FOV: 45 degrees · color fundus image: 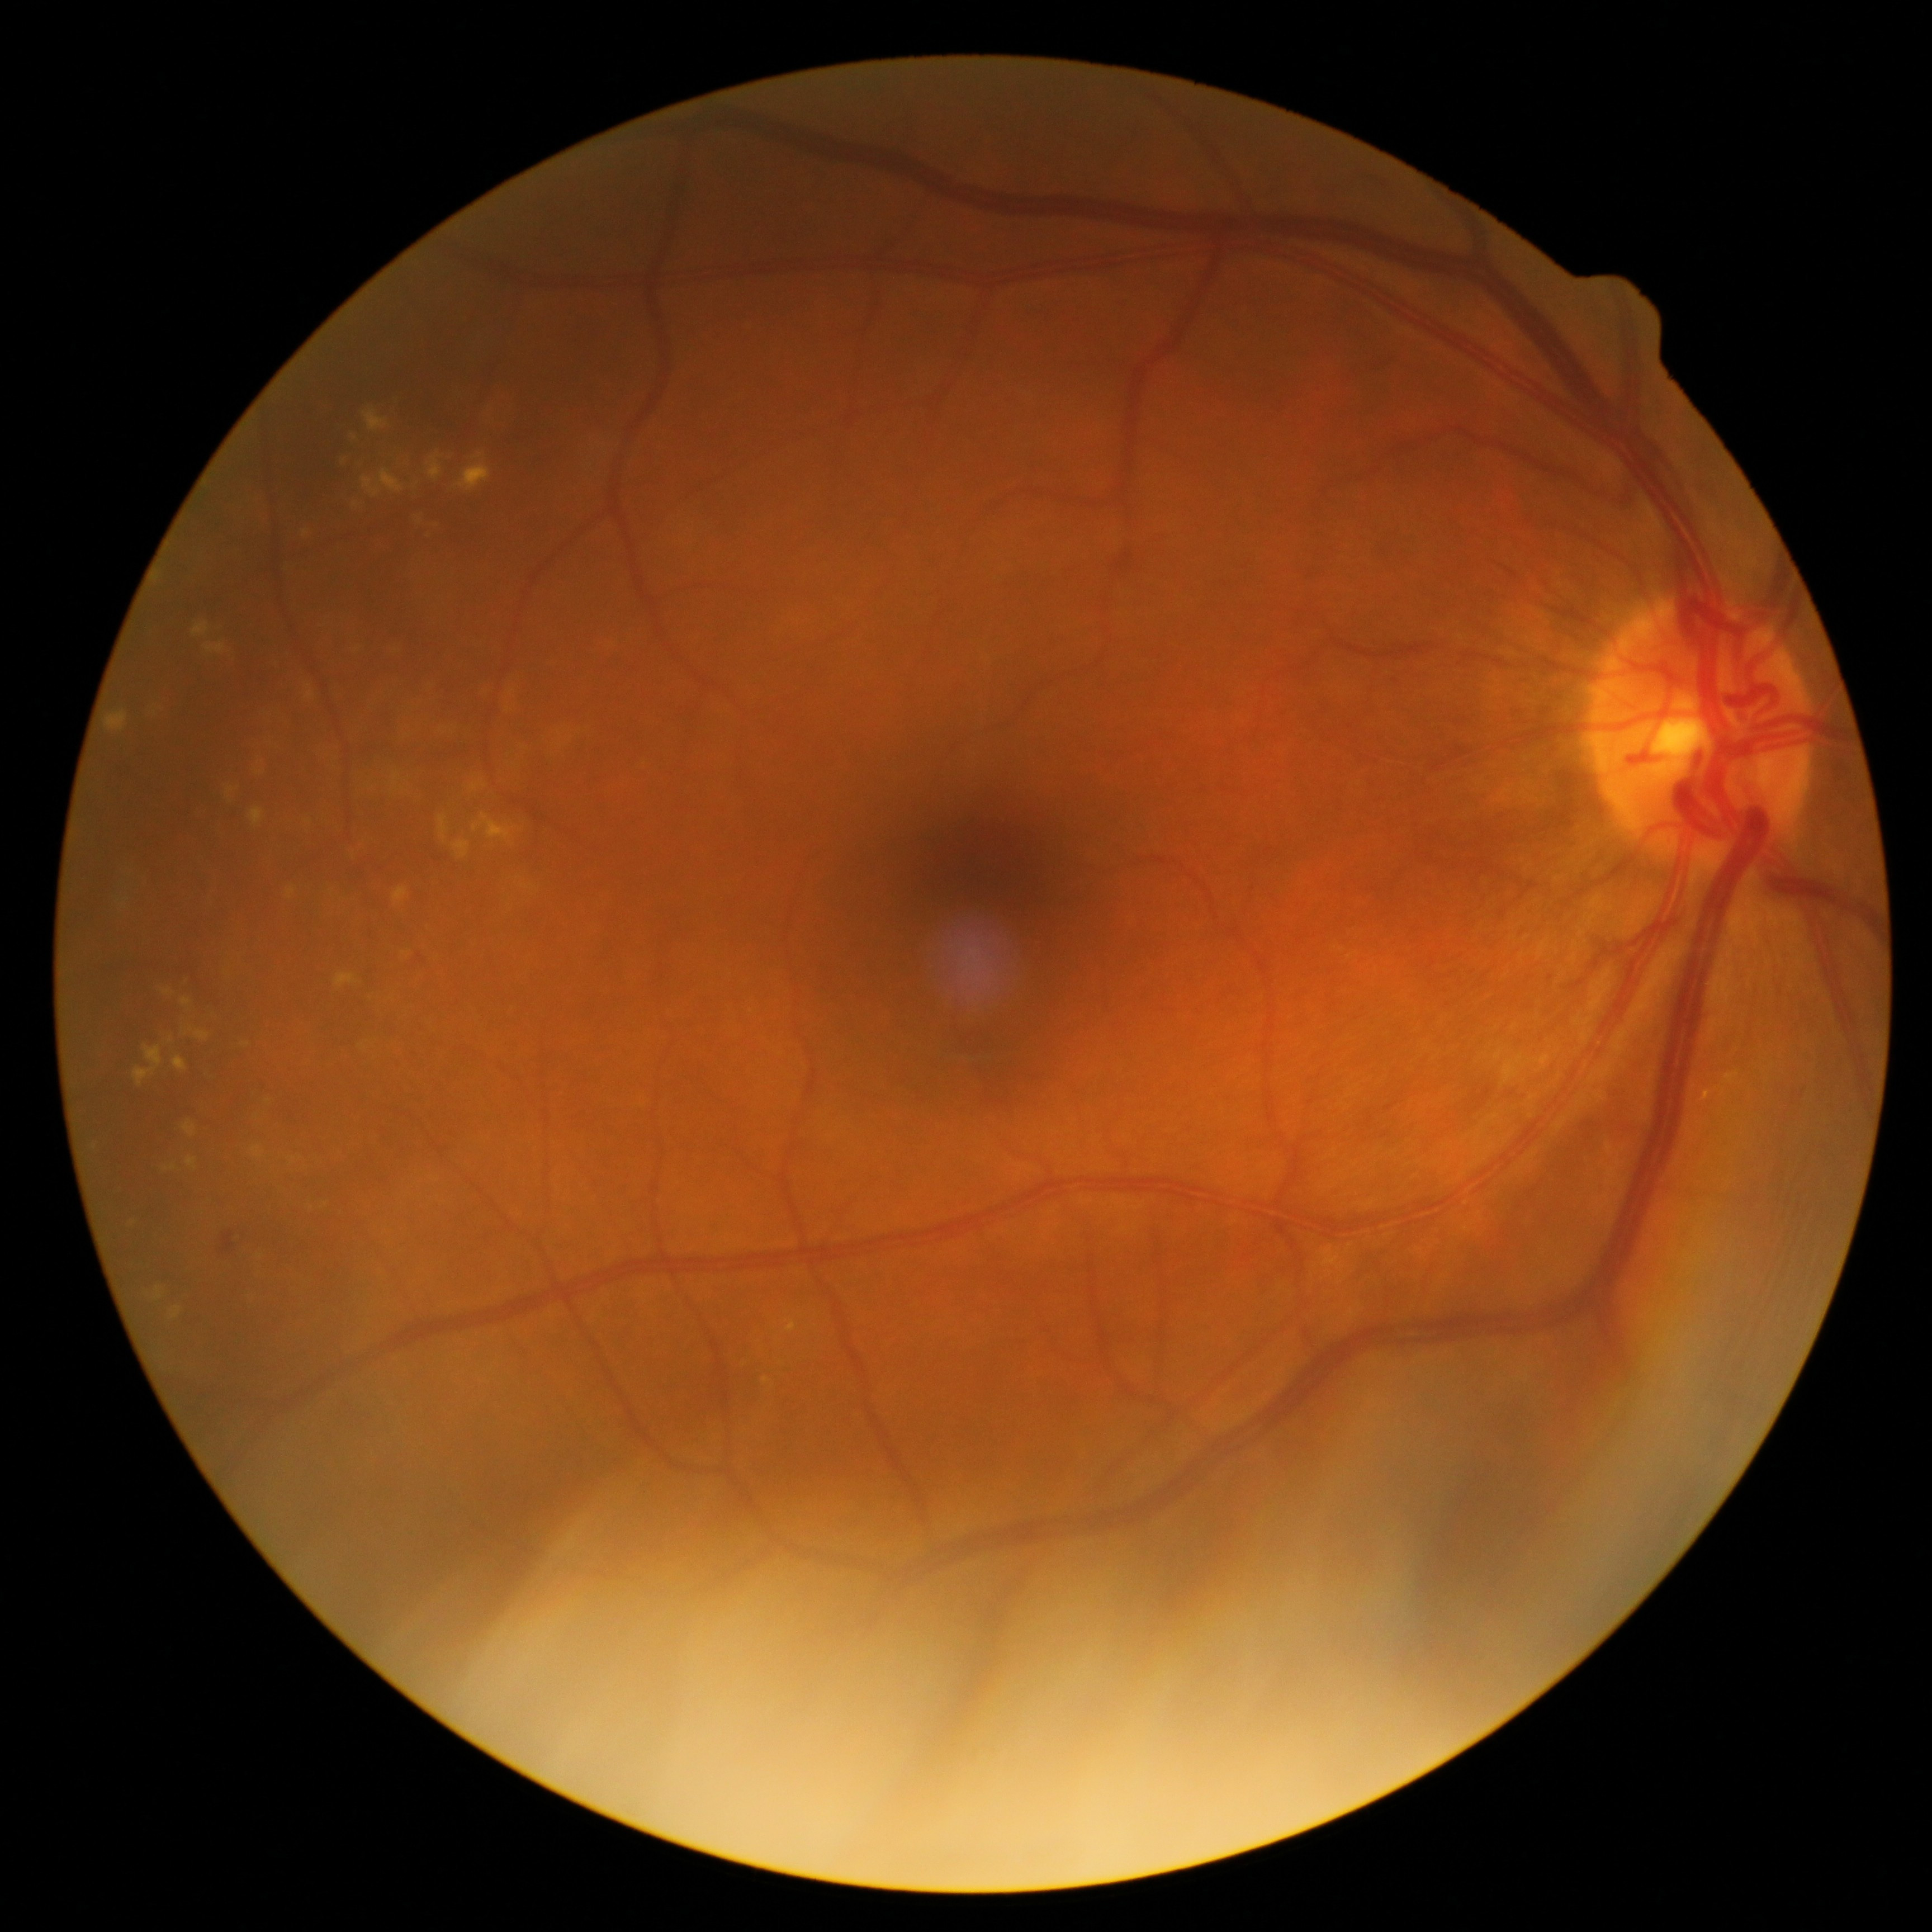
DR stage: grade 2.